Phoenix ICON, 100° FOV · image size 1240x1240 · wide-field fundus photograph from neonatal ROP screening: 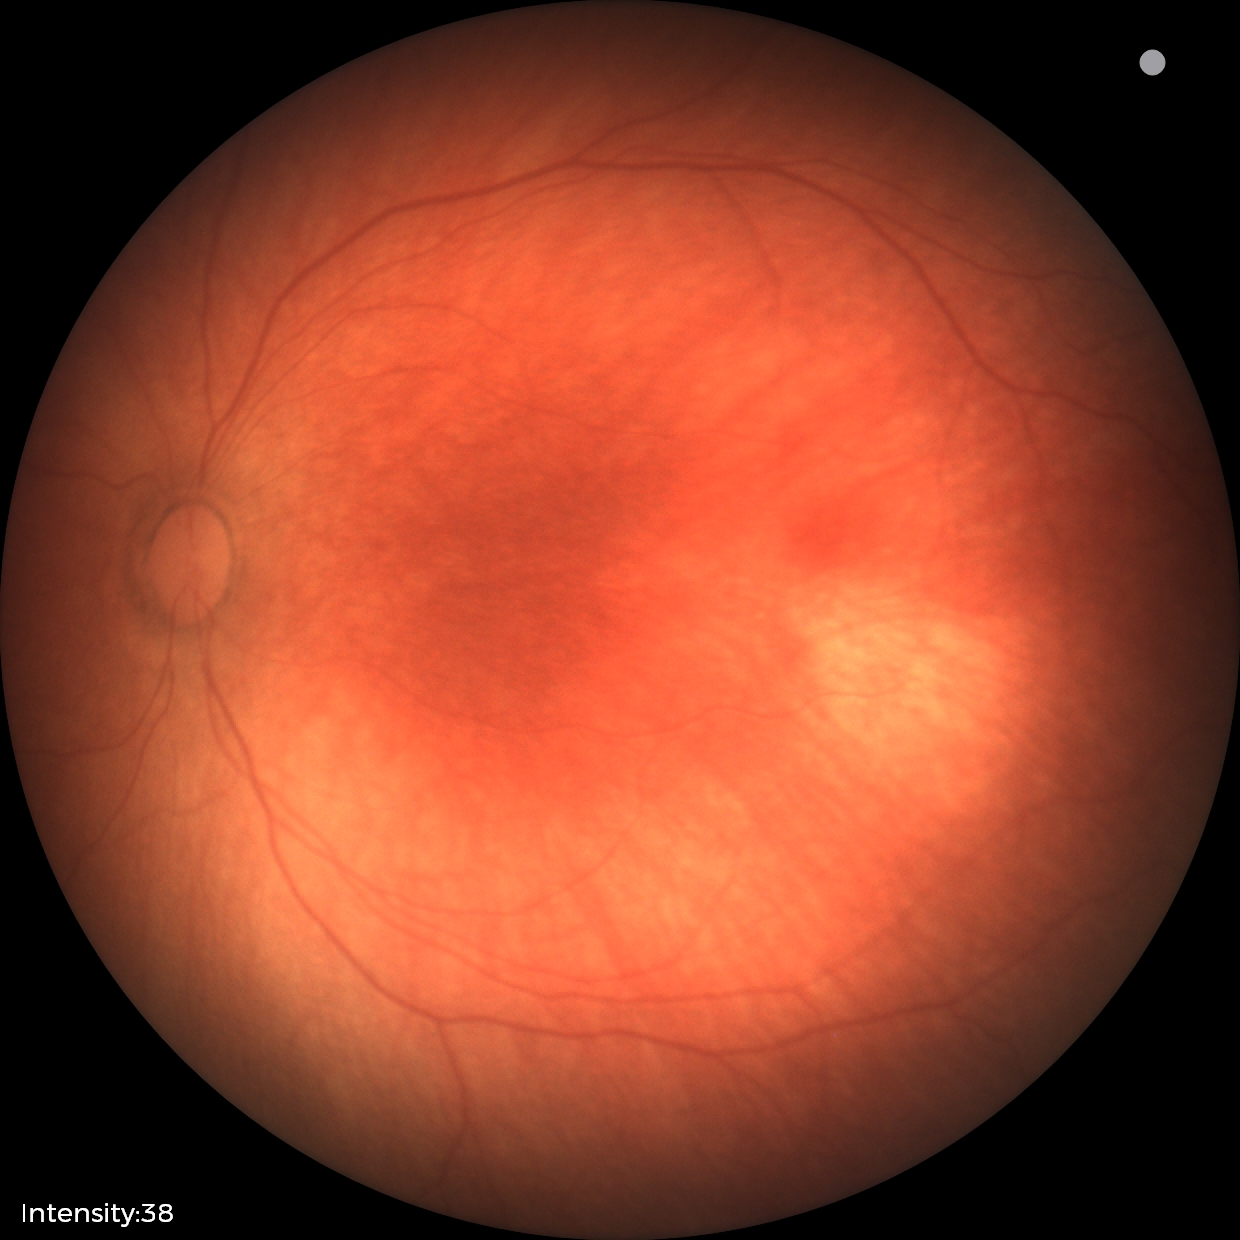
Q: What was the screening finding?
A: physiological appearance with no retinal pathology